Retinal fundus photograph: 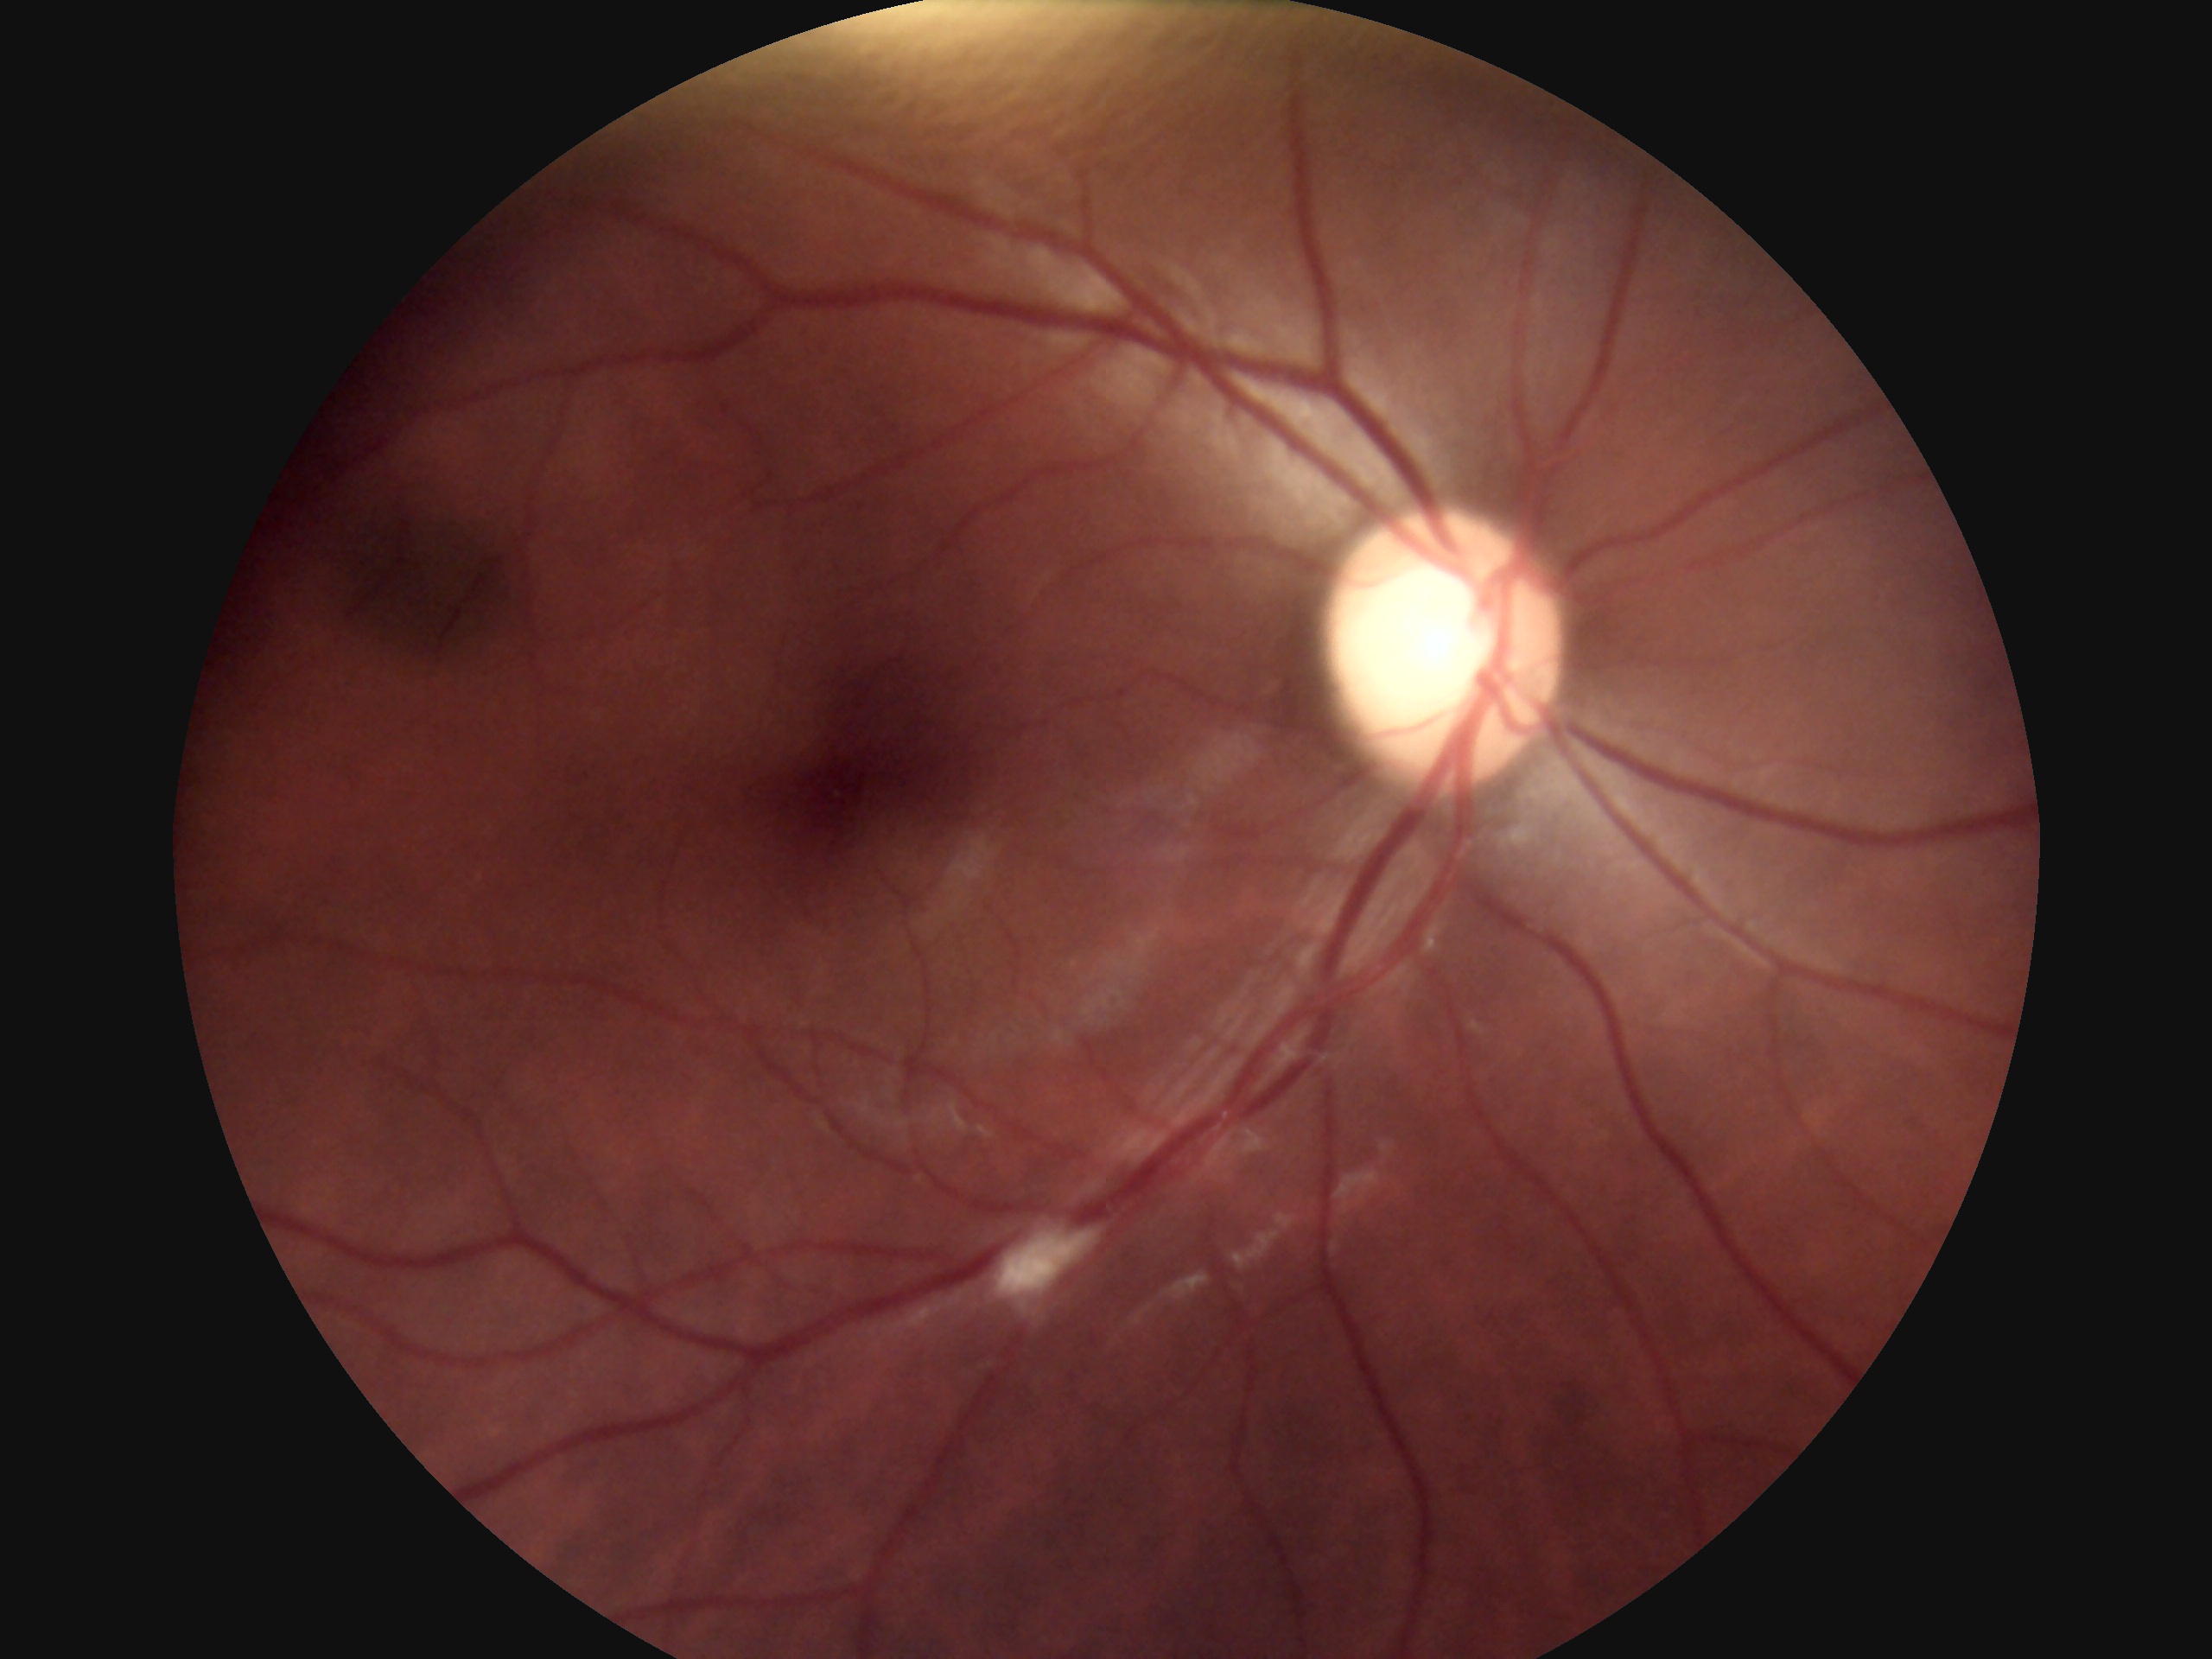
{"dr_grade": "grade 2 (moderate NPDR)"}